45° field of view: 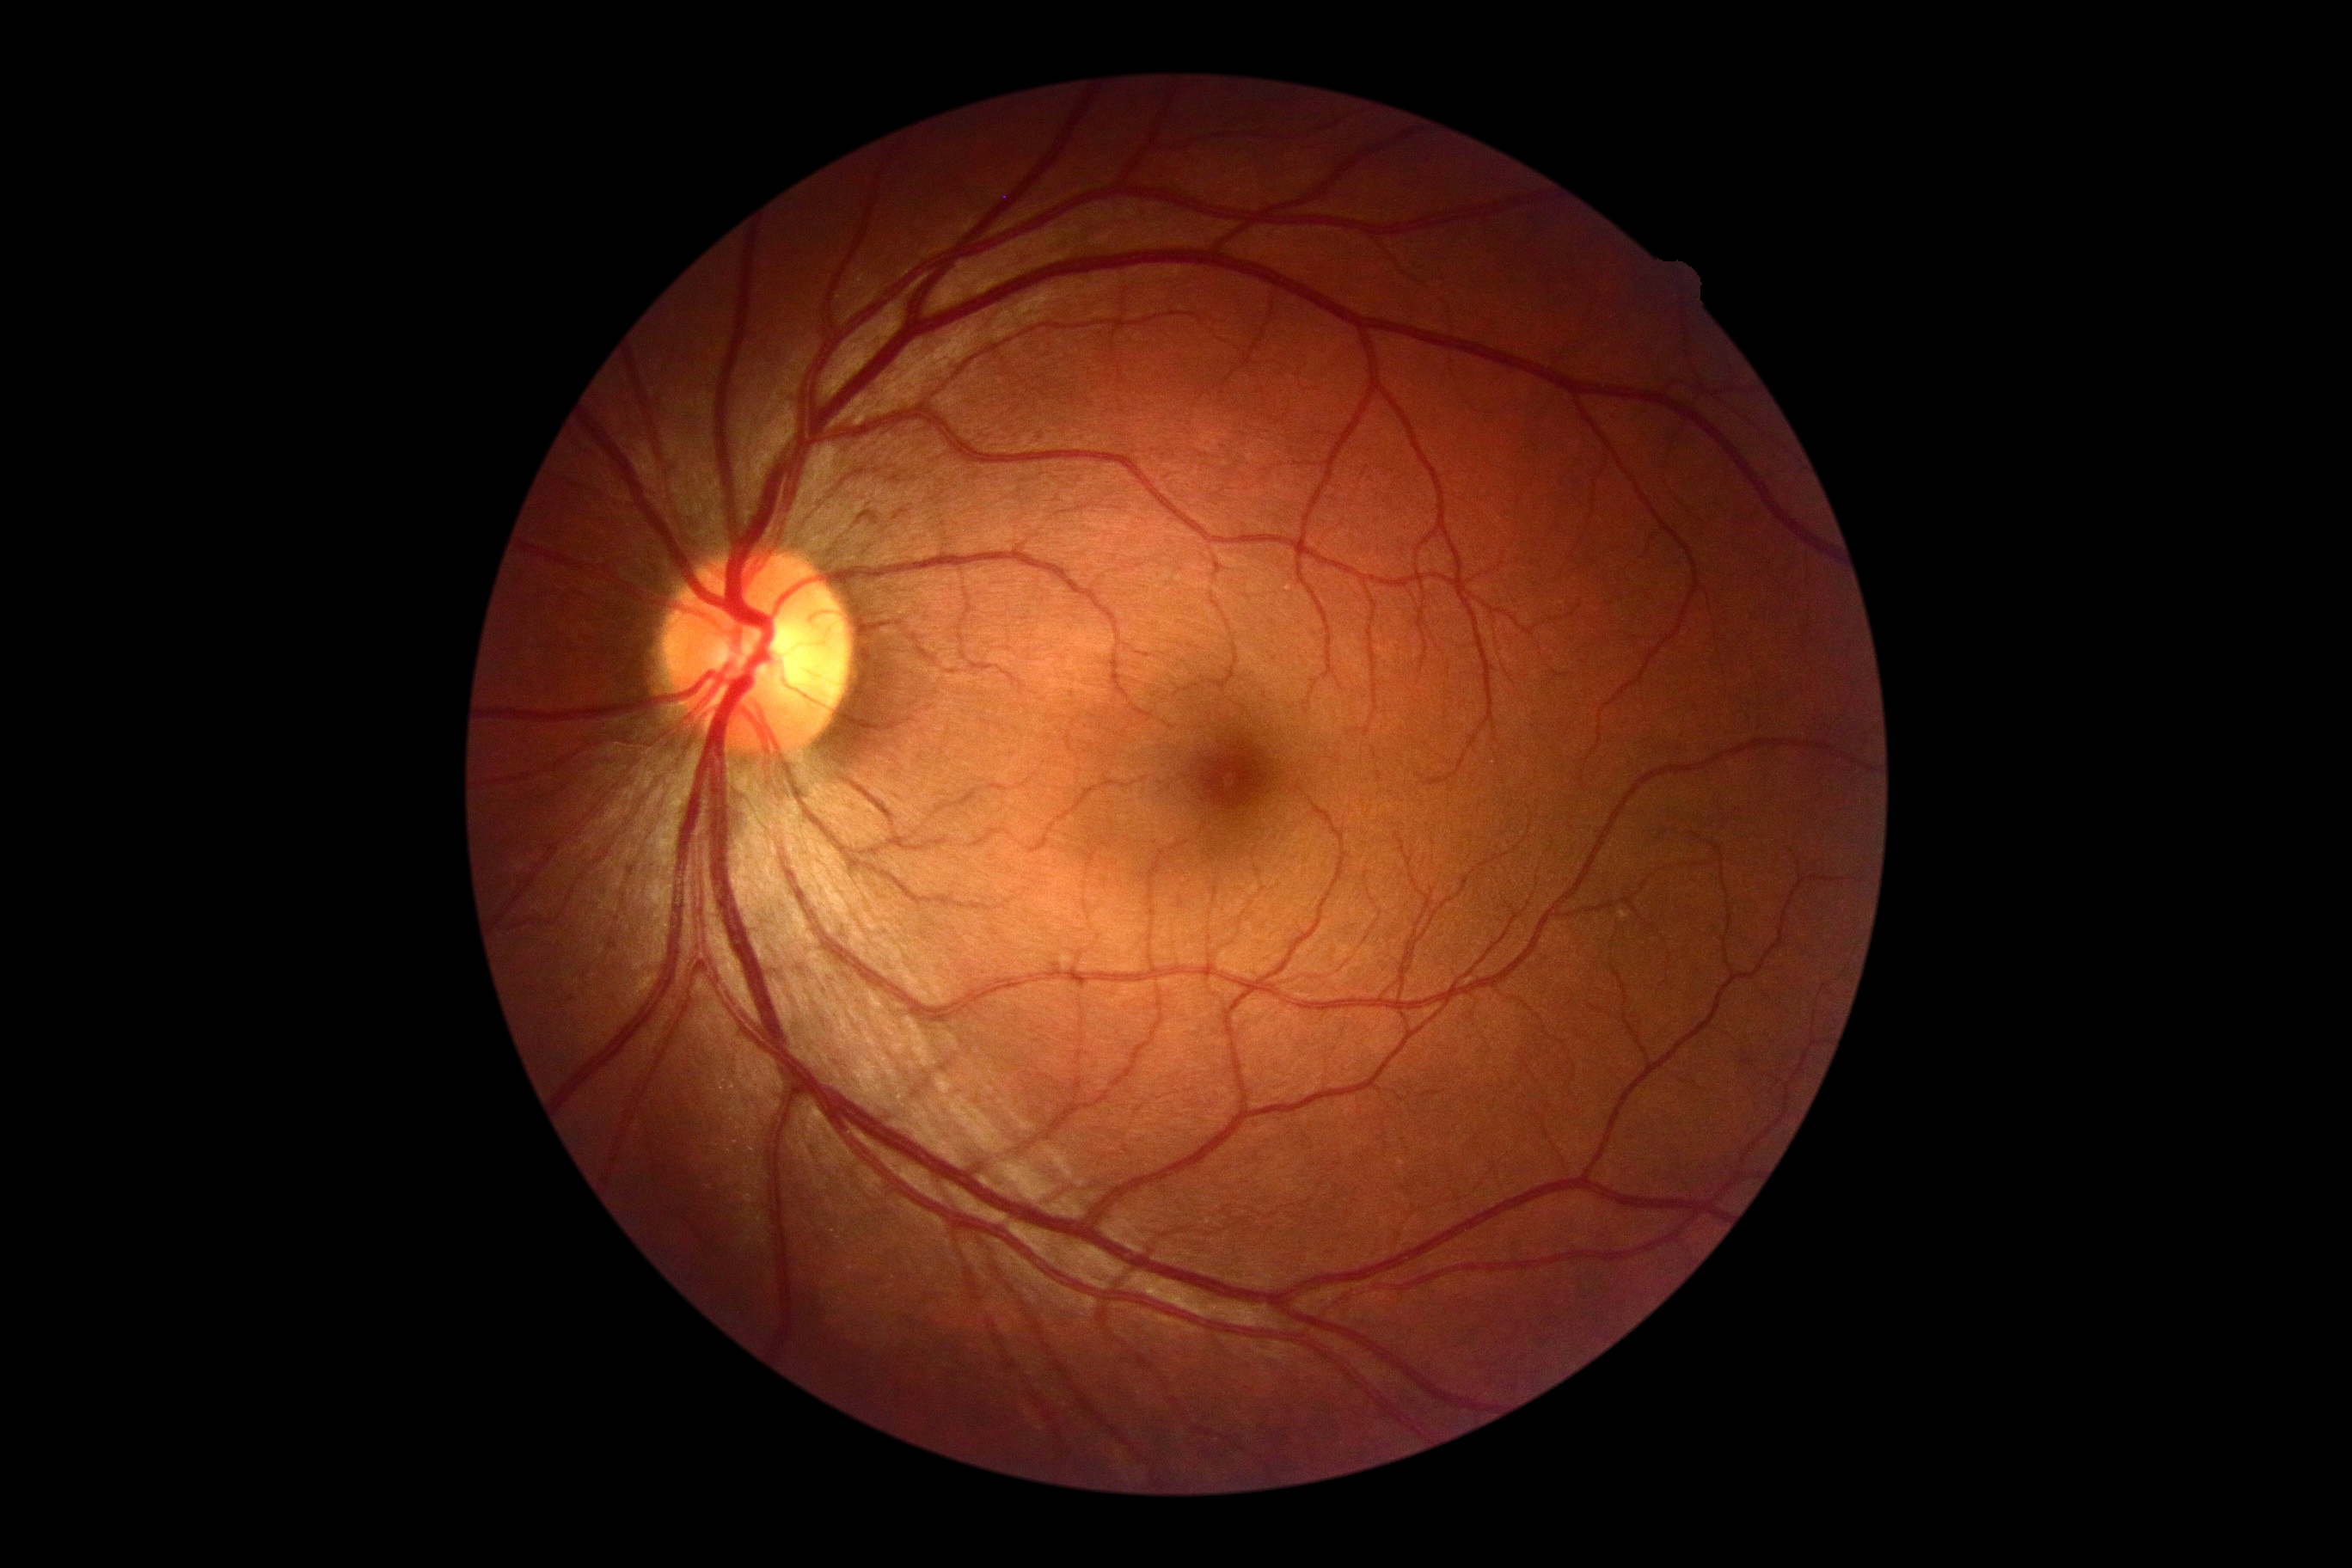 Retinopathy is no apparent retinopathy (grade 0).